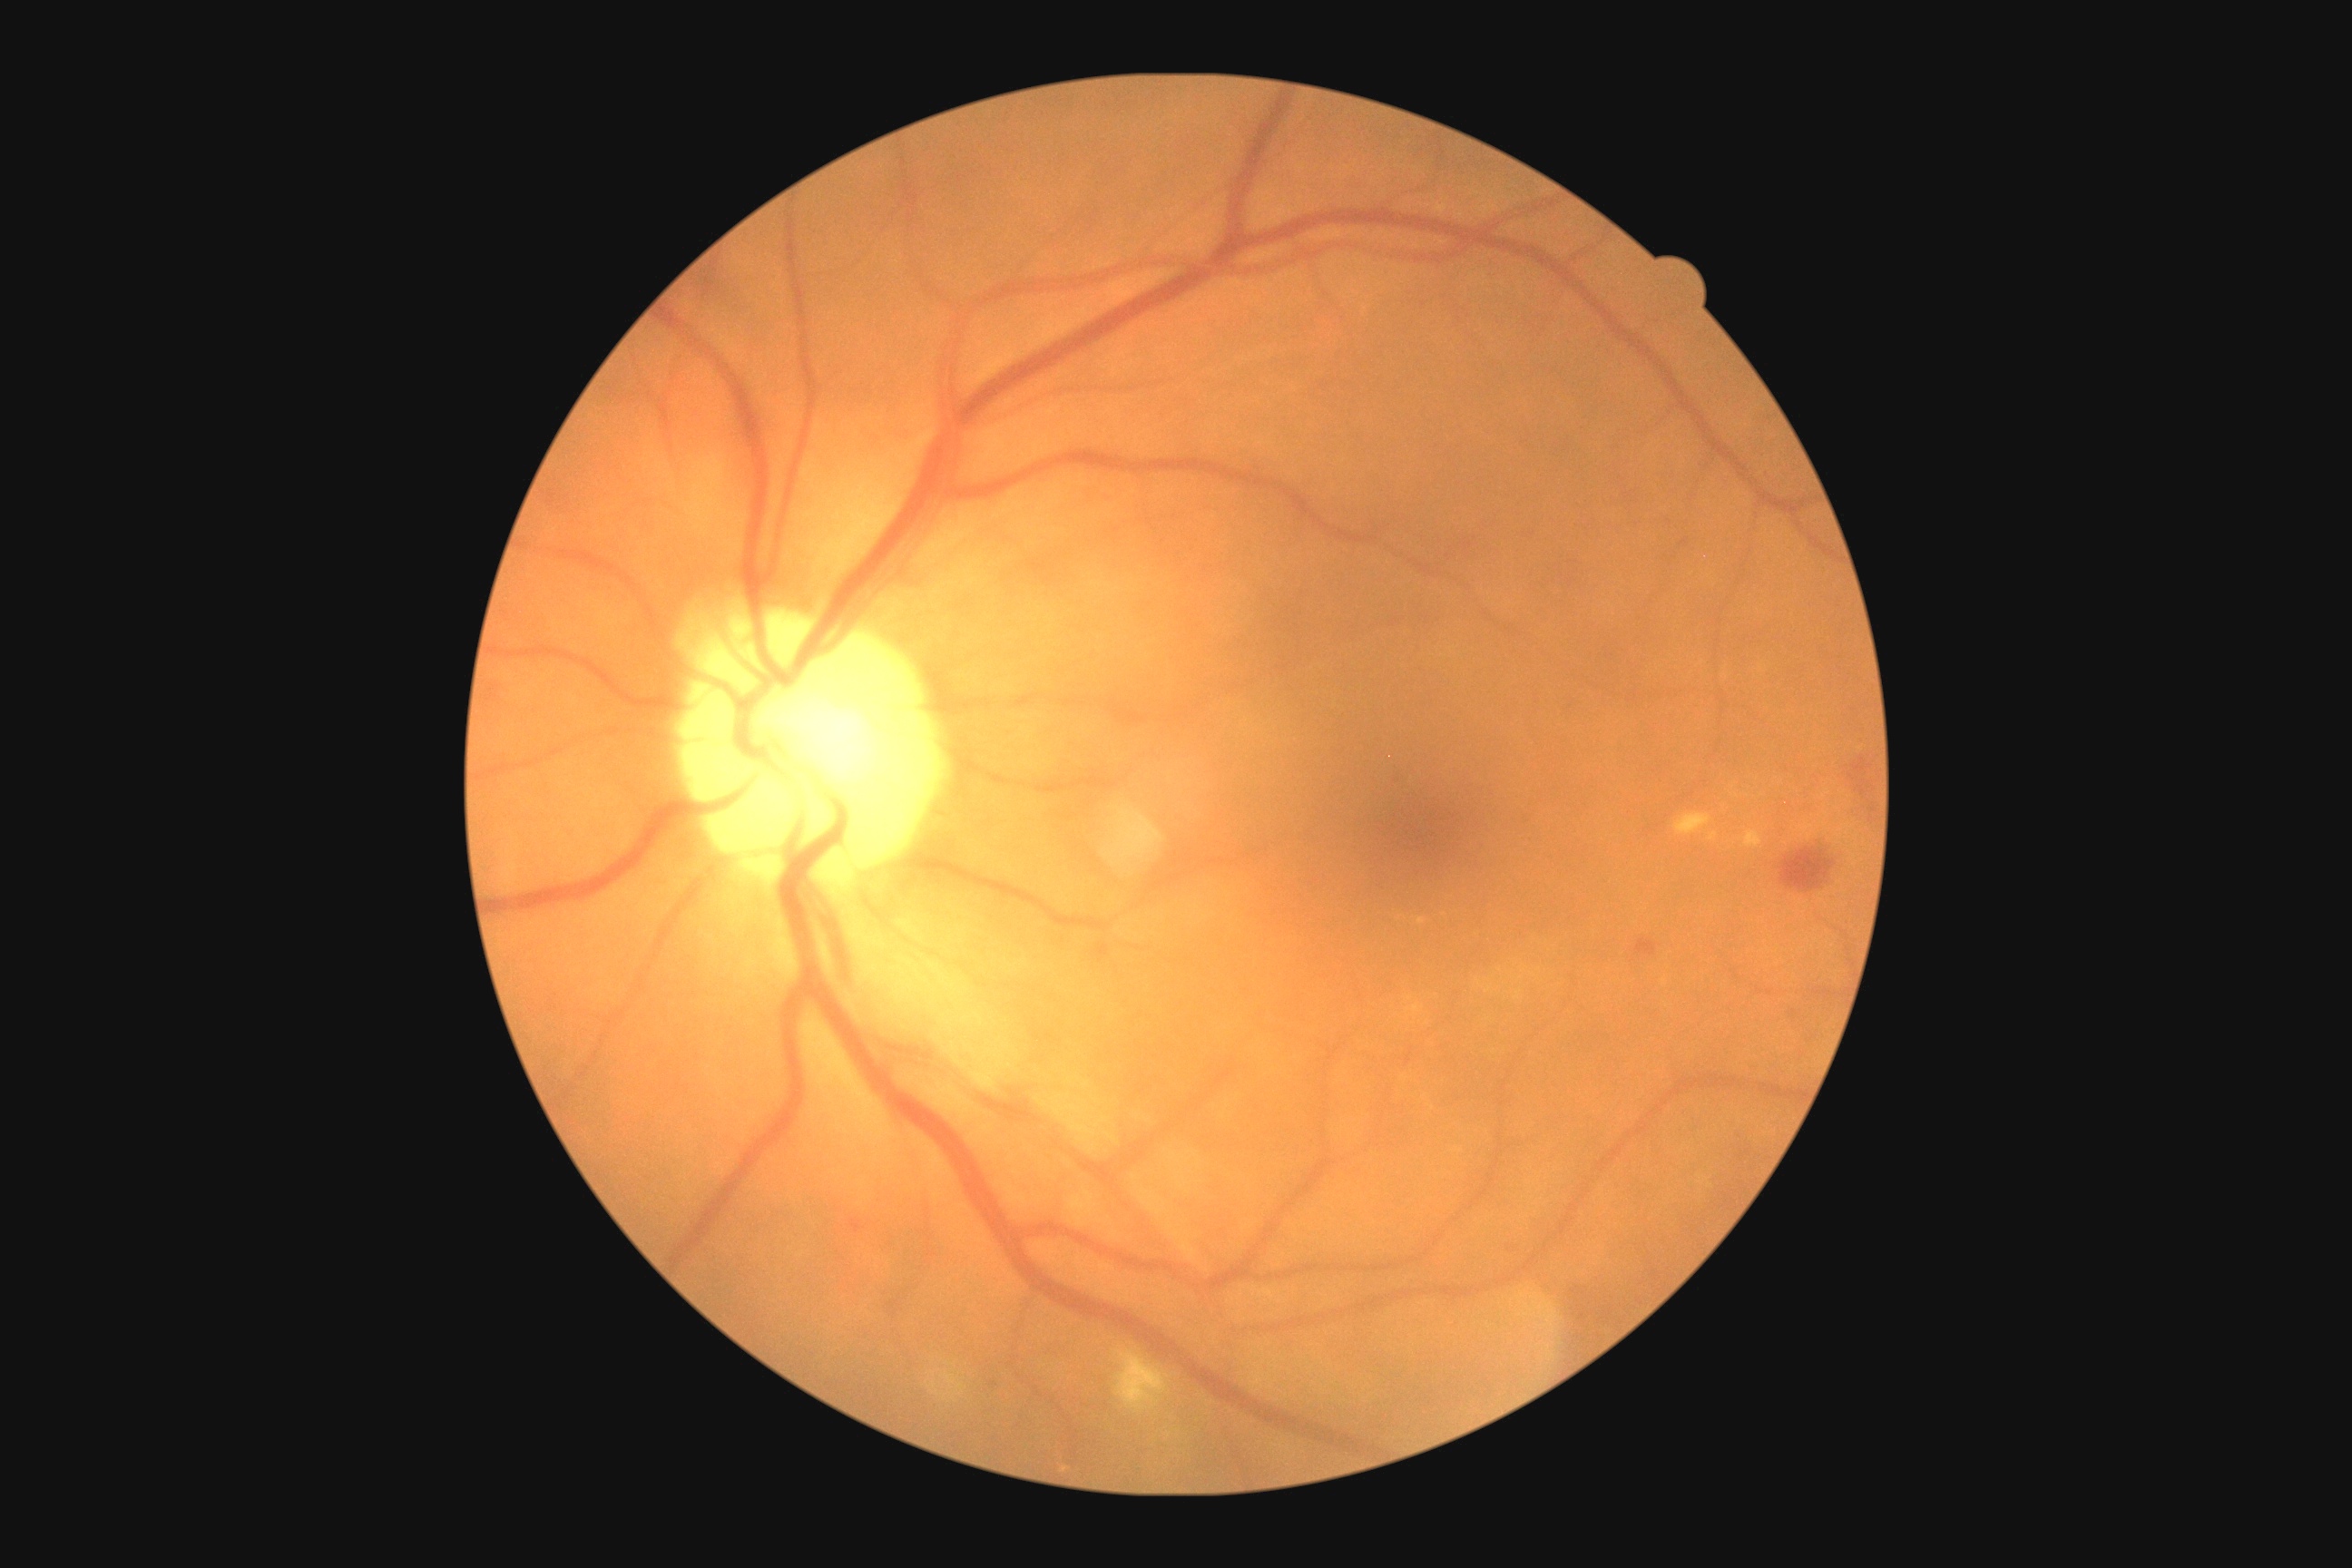 DR severity is moderate non-proliferative diabetic retinopathy (grade 2).